Pediatric retinal photograph (wide-field); captured with the Natus RetCam Envision (130° field of view): 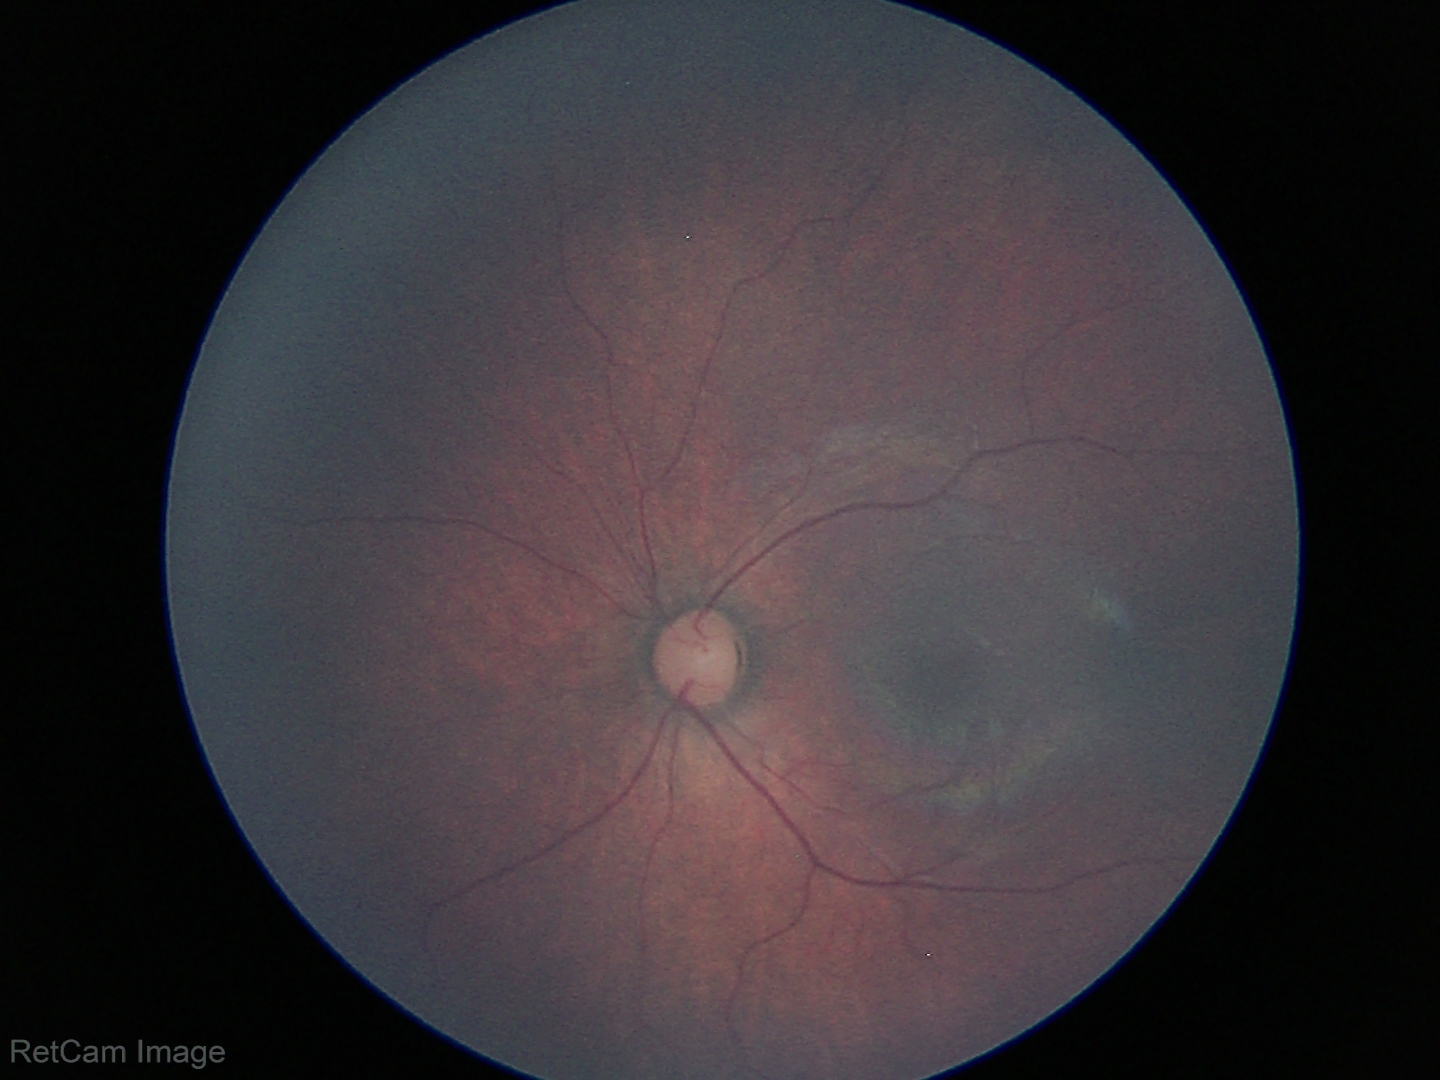

Screening examination diagnosed as physiological.